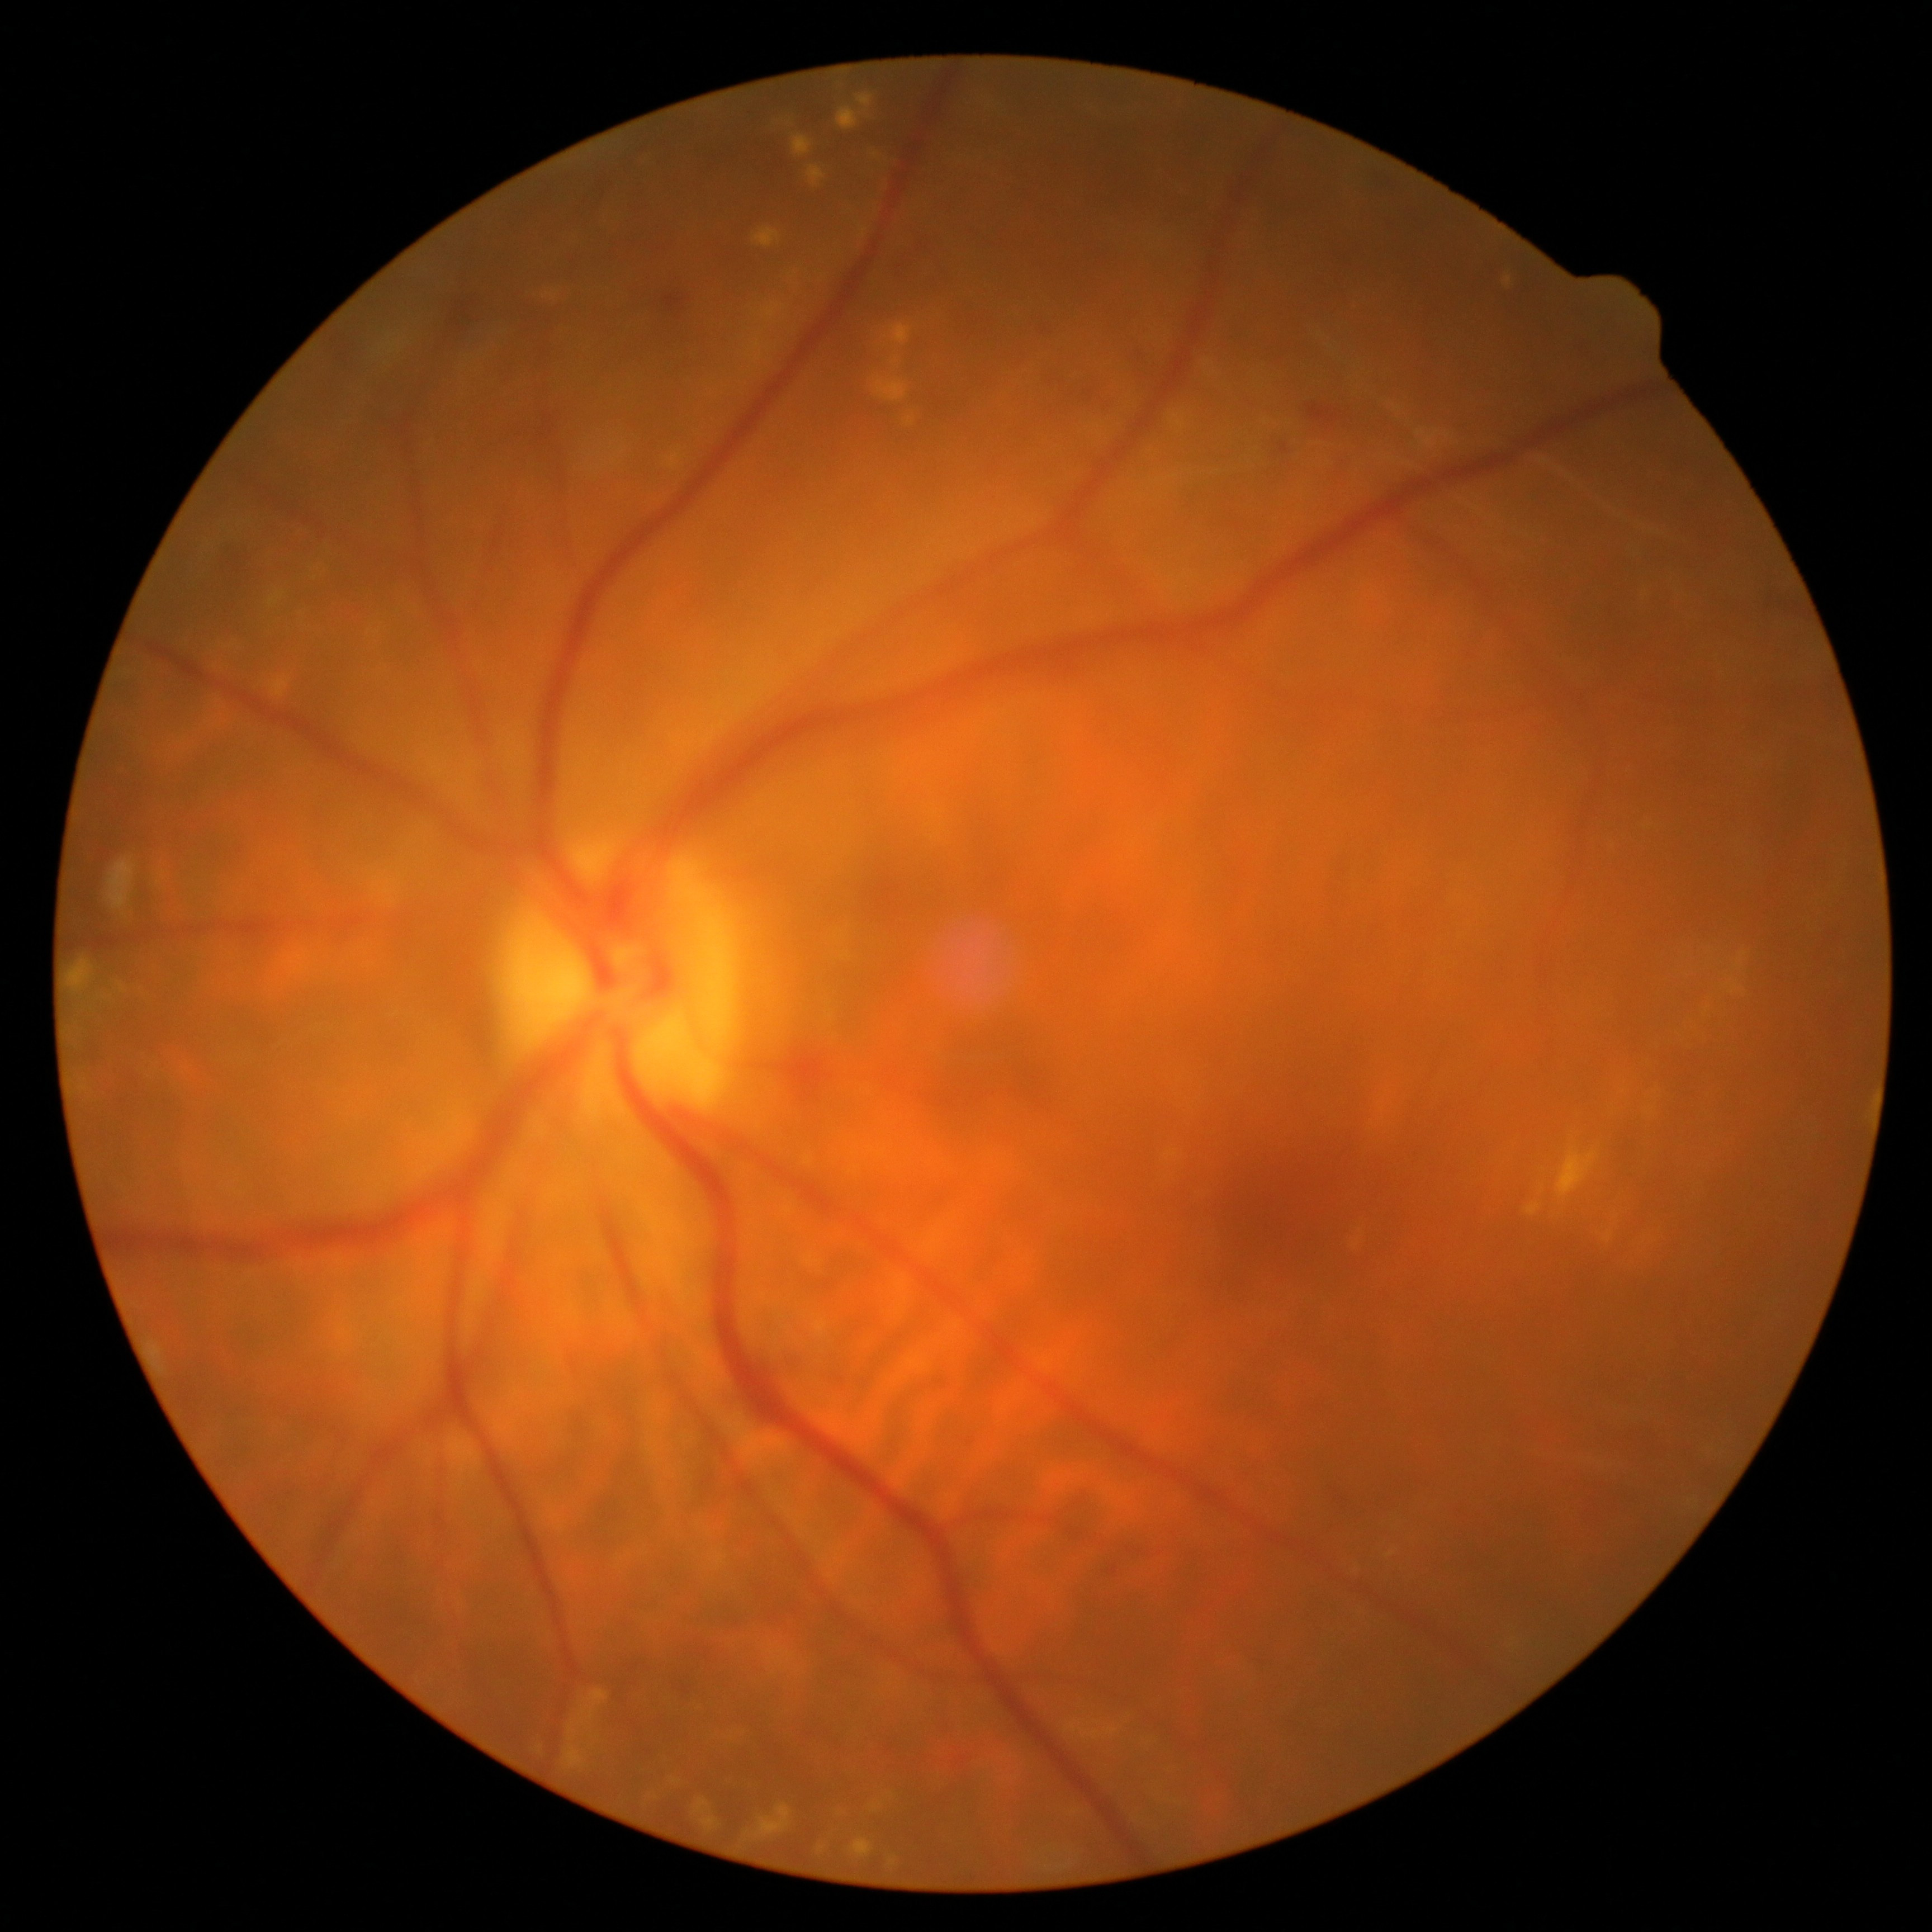 DR is 2.